CFP — 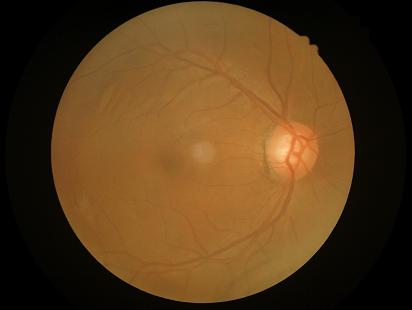 Quality grading: contrast: low, vessels and details hard to distinguish | sharpness: clear with no noticeable blur | overall: adequate for clinical interpretation.